FOV: 45 degrees · fundus photo:
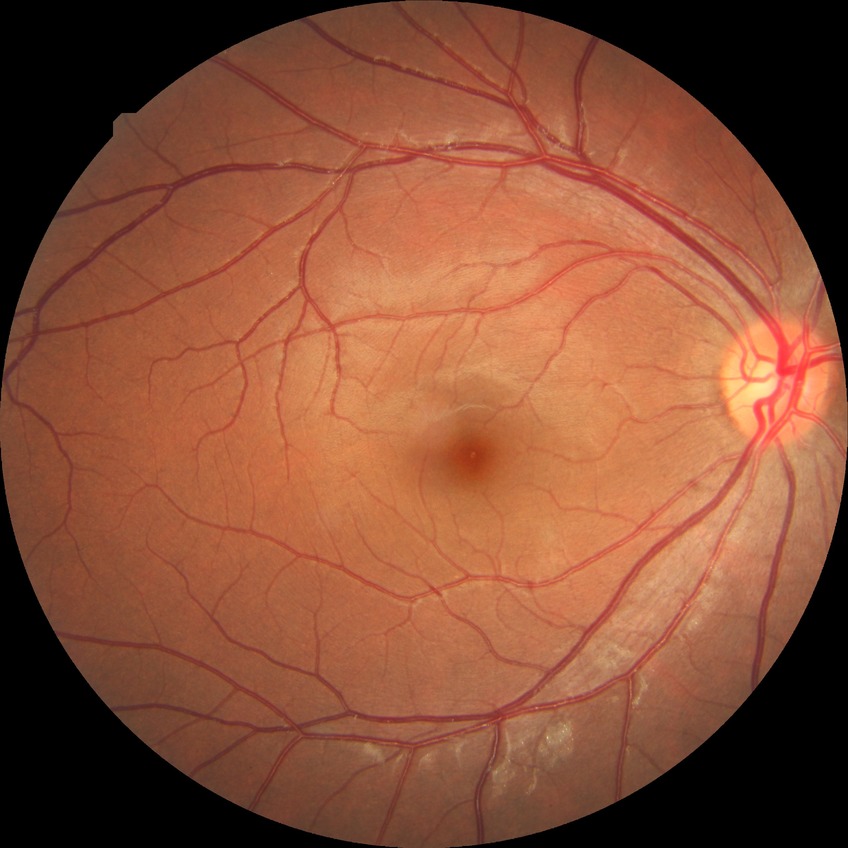
diabetic retinopathy (DR): NDR (no diabetic retinopathy).